Modified Davis classification — 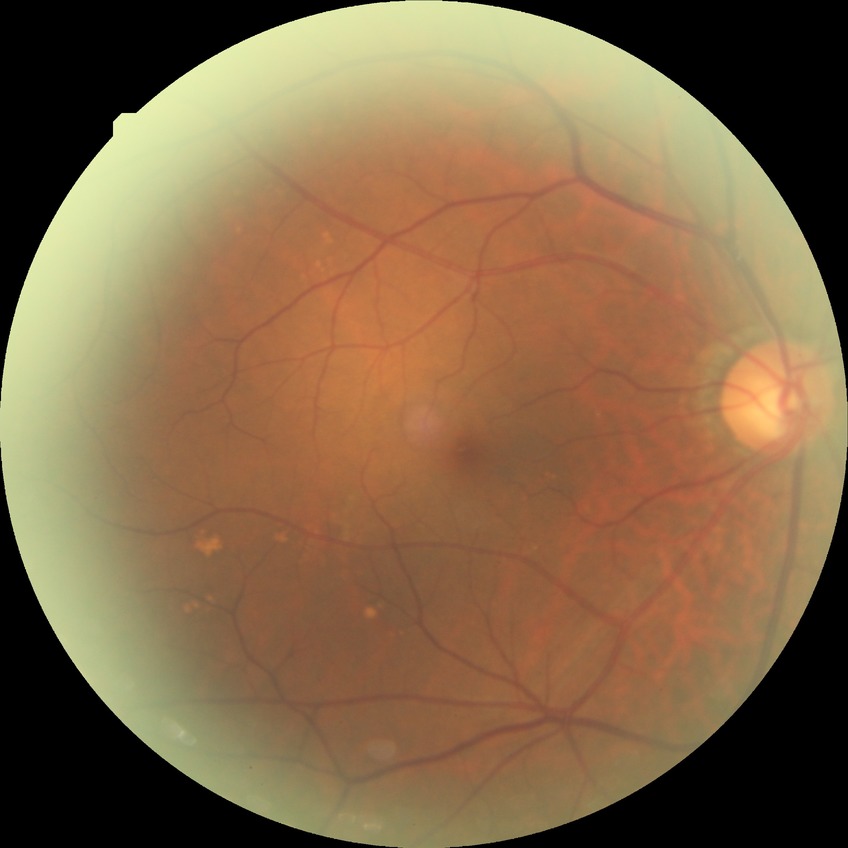 Diabetic retinopathy (DR) is no diabetic retinopathy (NDR).